CFP.
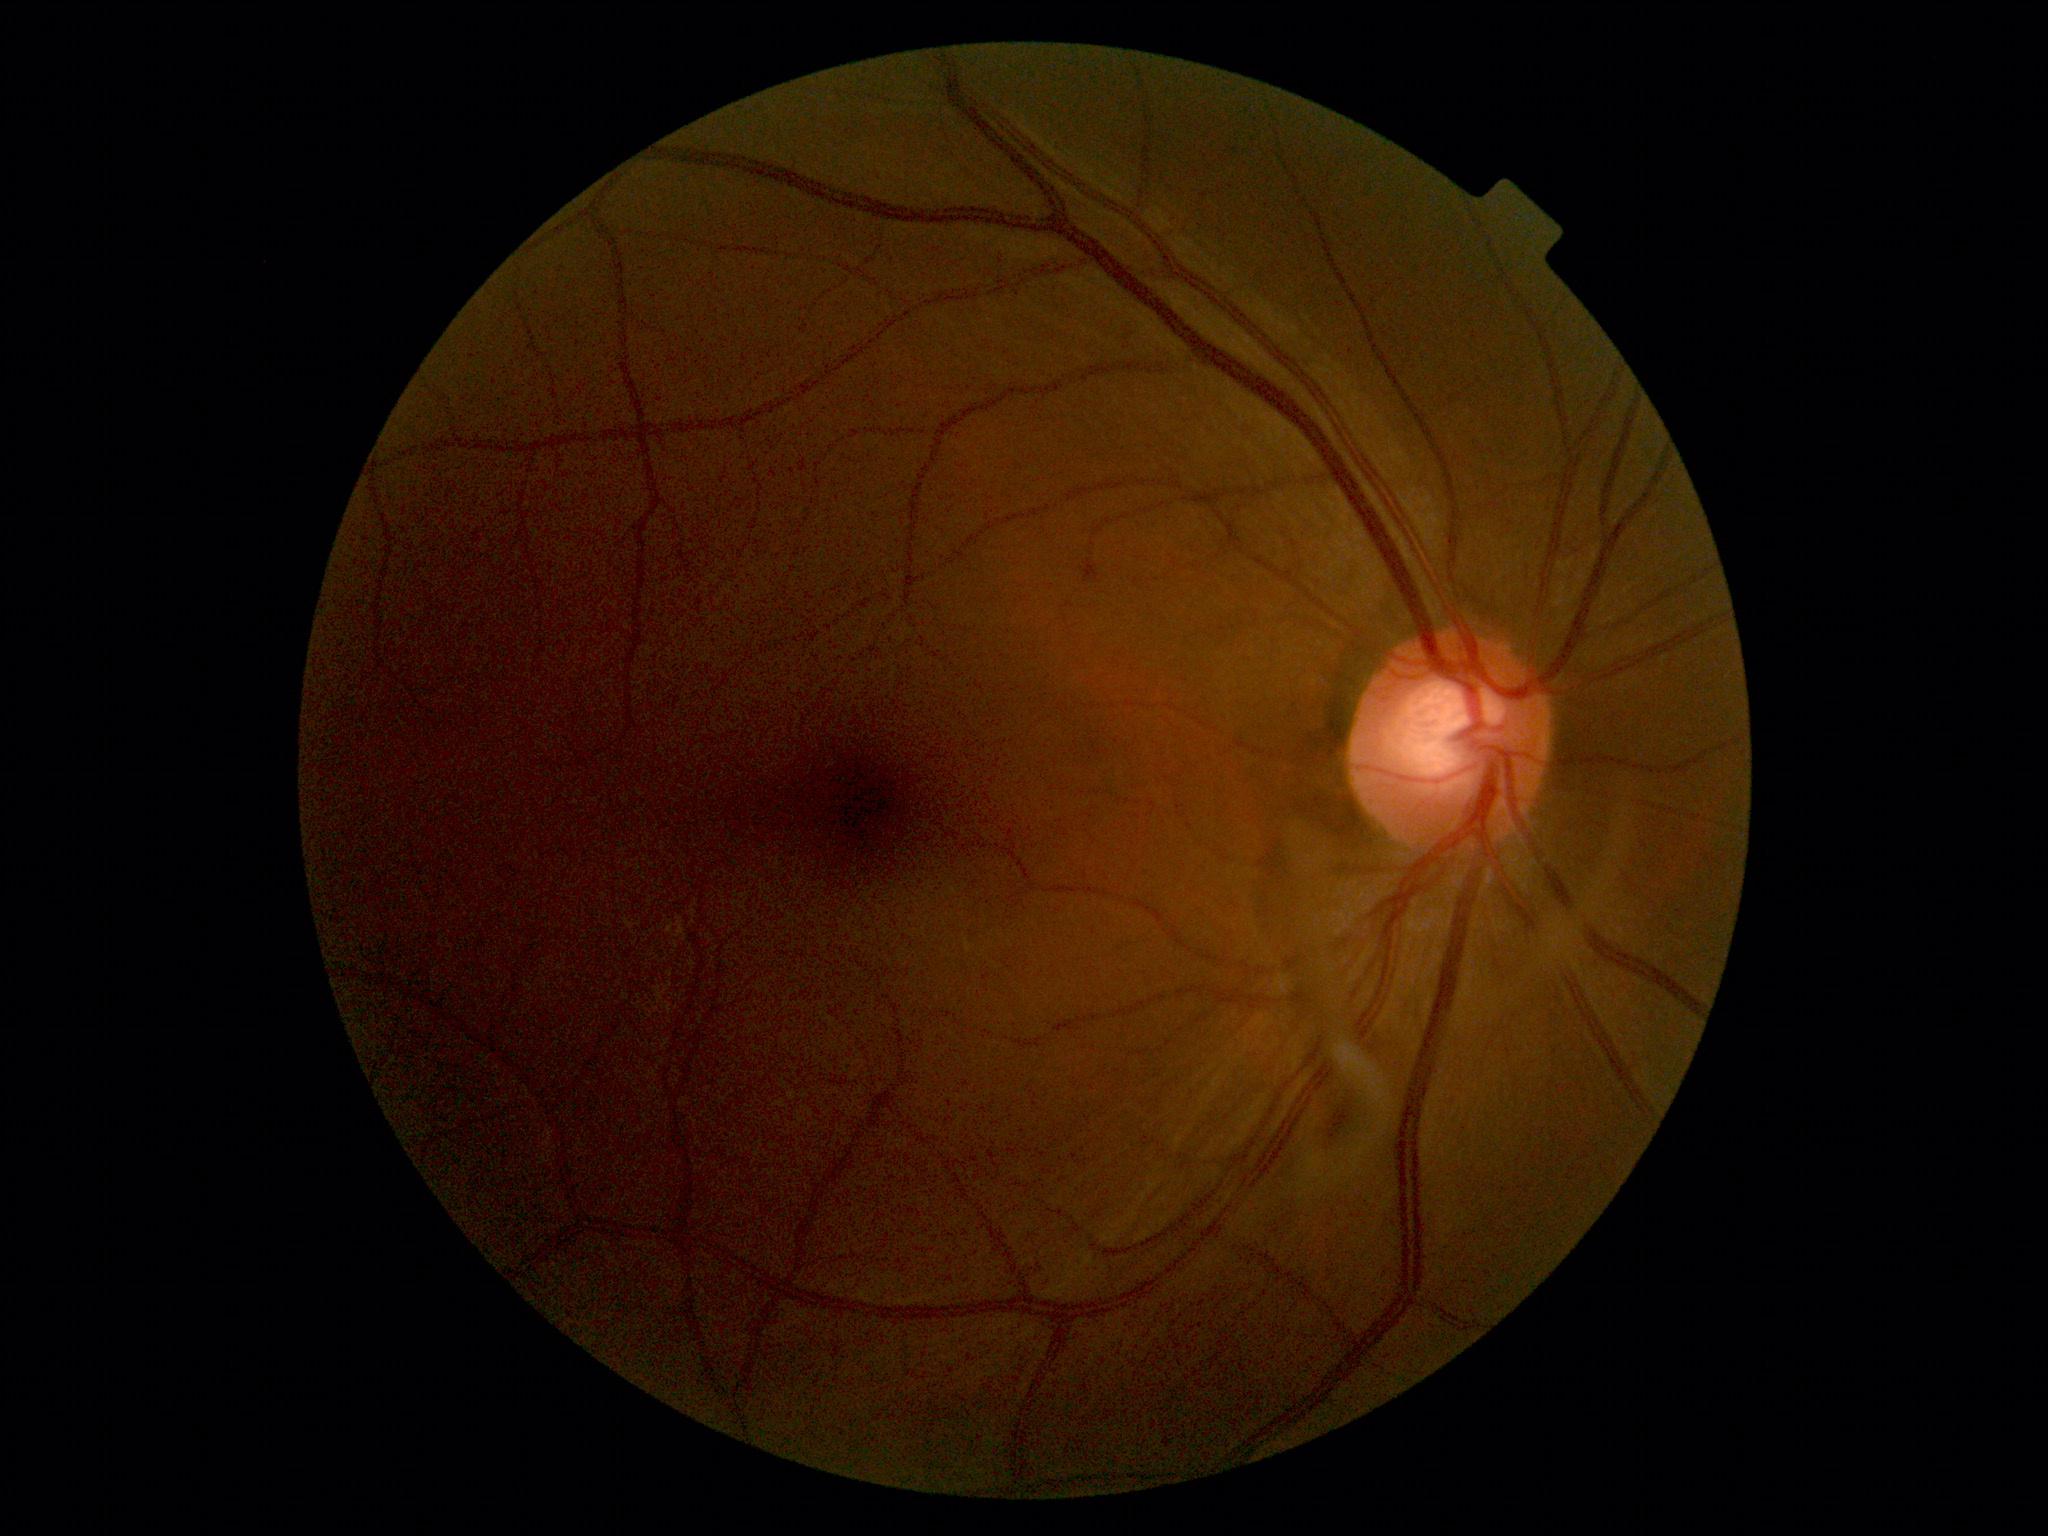

Findings:
– DR — 0/4
– DR impression — no signs of DR